Posterior pole color fundus photograph · image size 848x848 · DR severity per modified Davis staging.
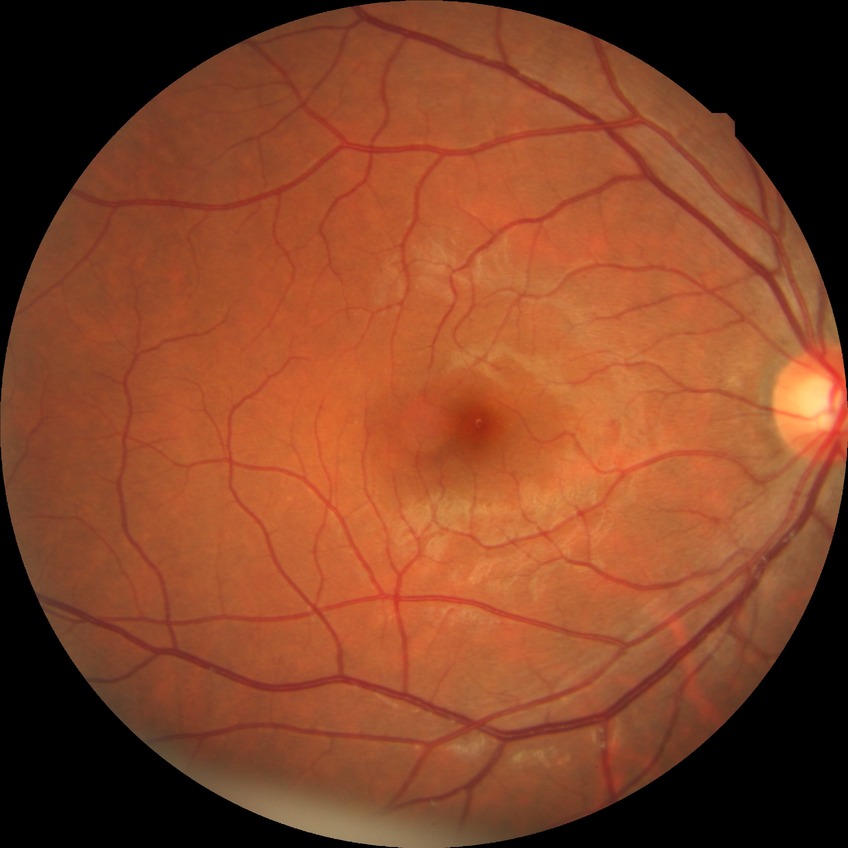
Retinopathy stage: no diabetic retinopathy.